FOV: 45 degrees.
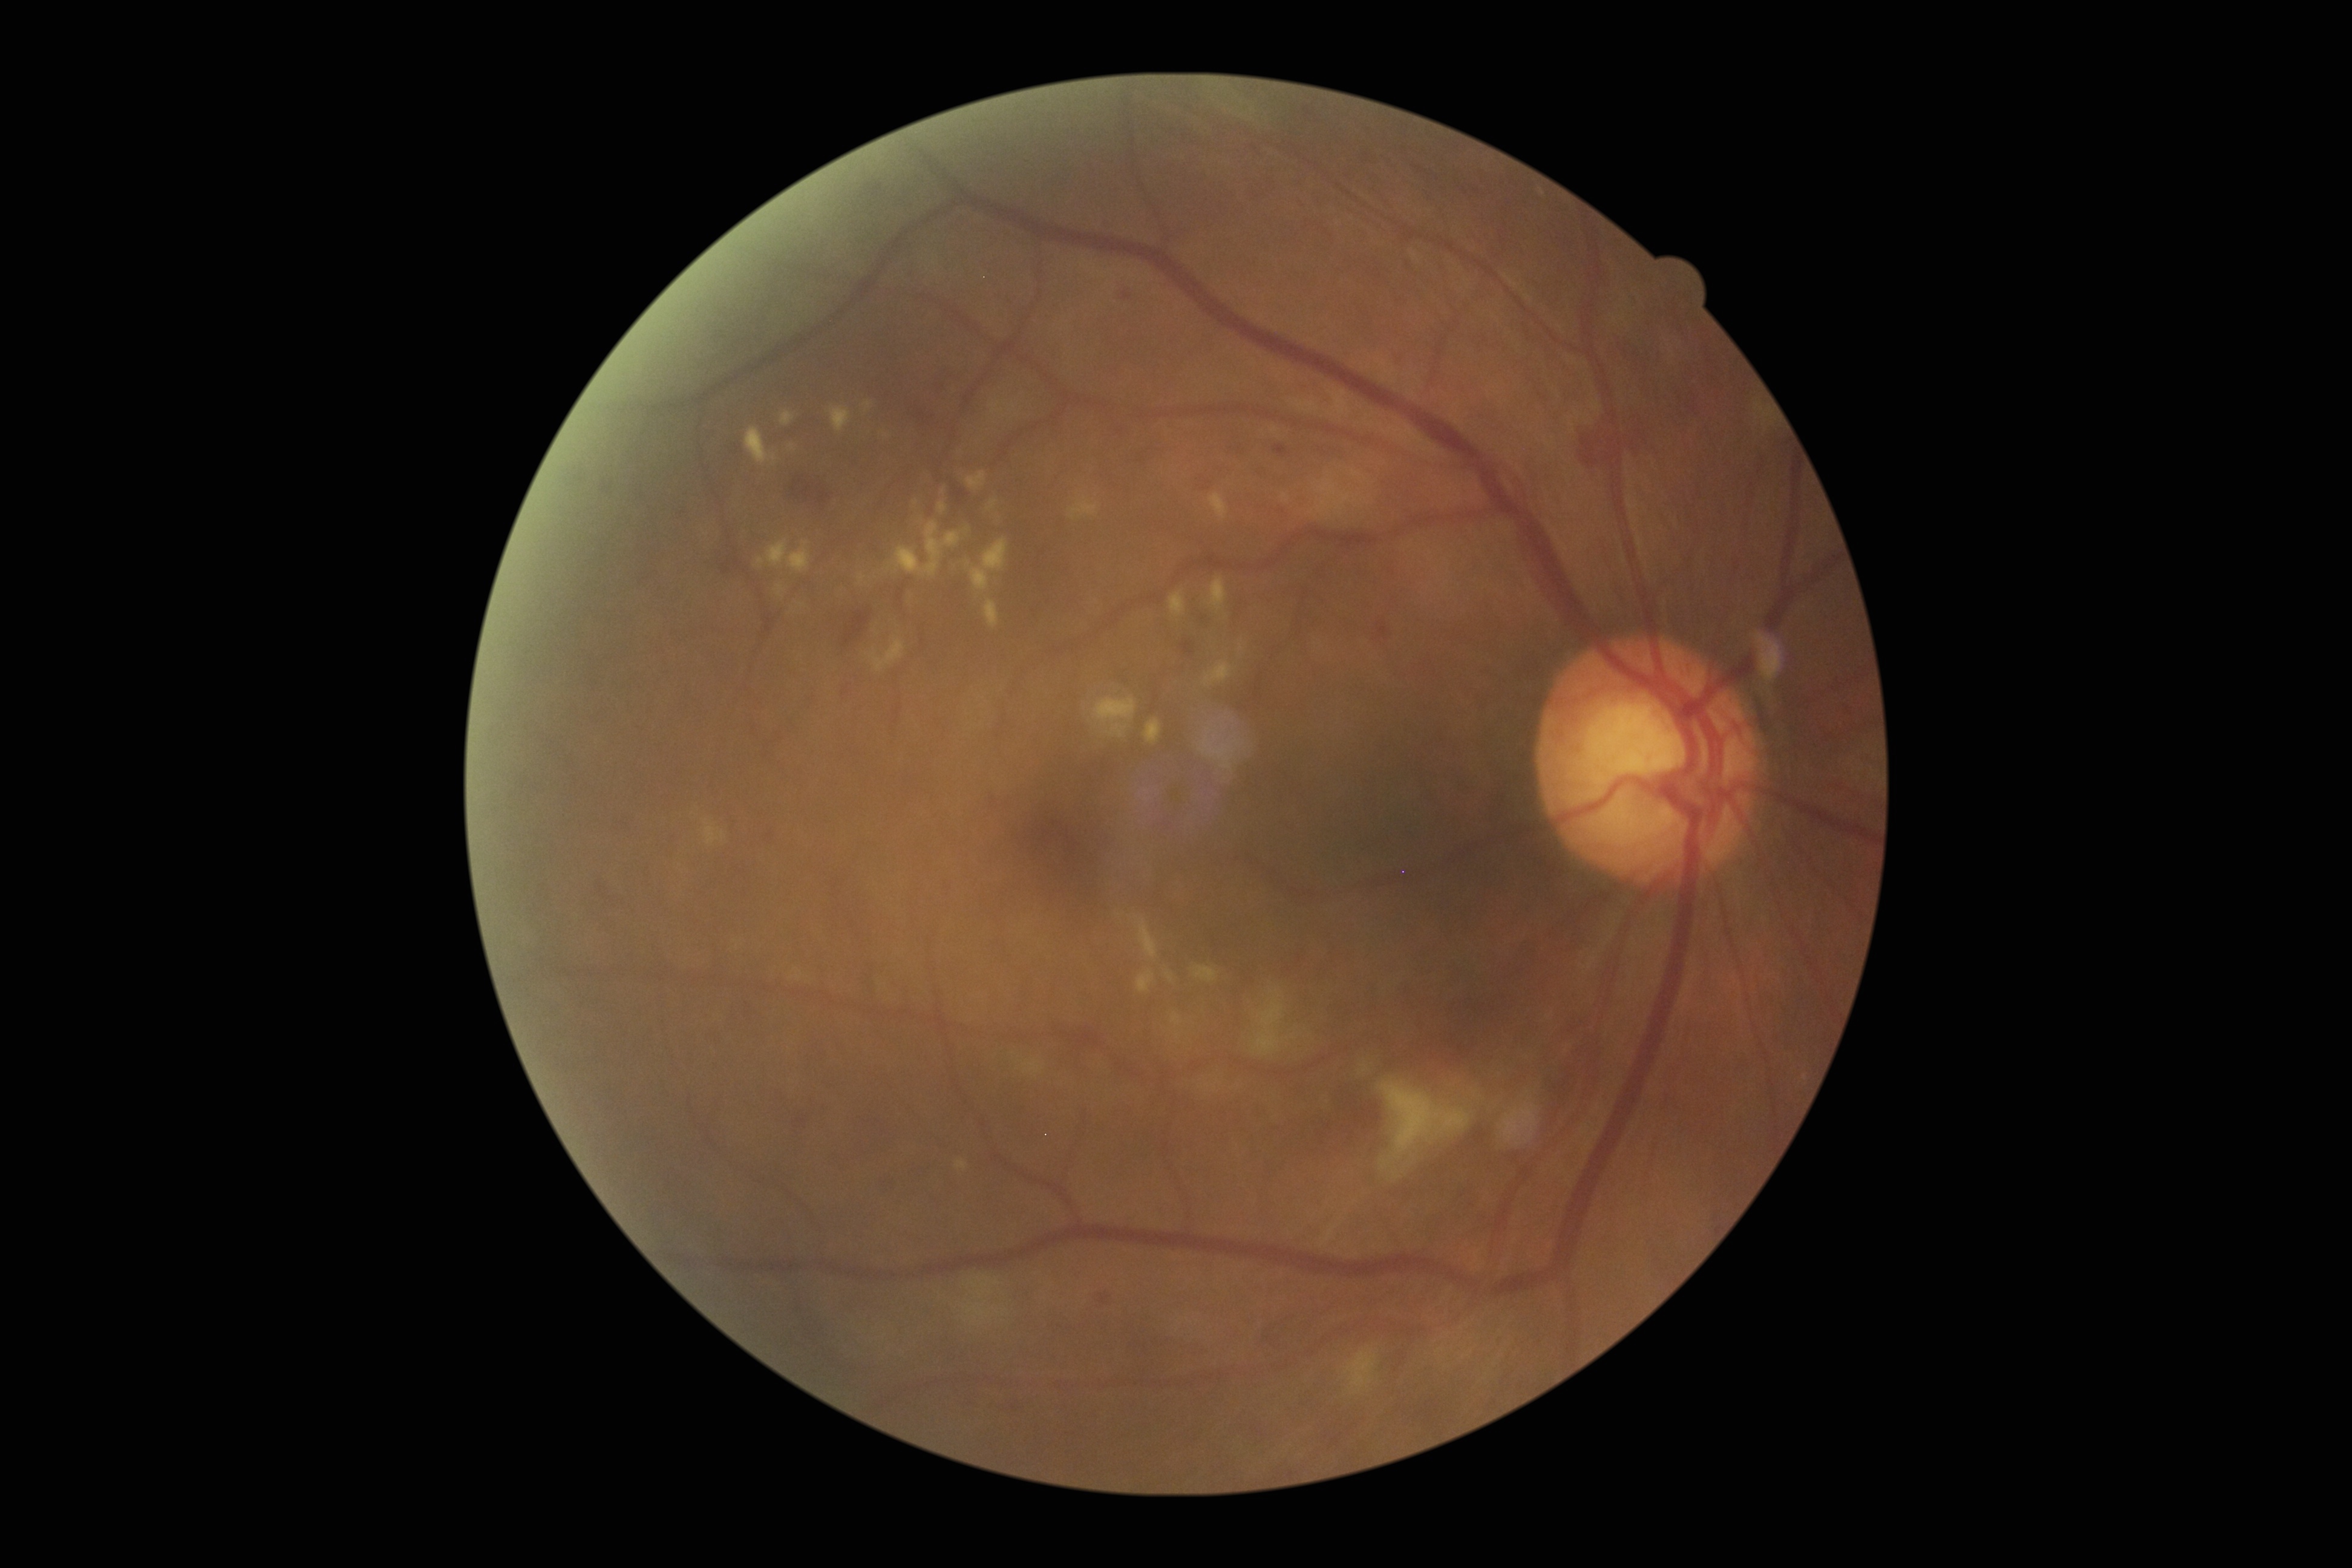
DR severity: 2. DR class: non-proliferative diabetic retinopathy.